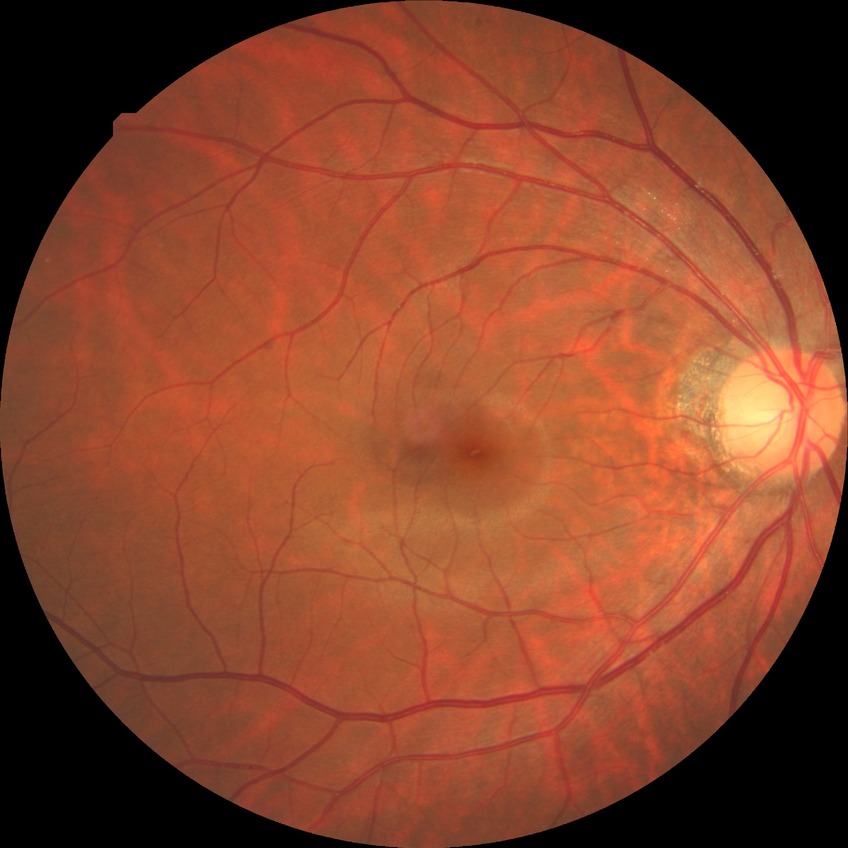

diabetic retinopathy (DR)=NDR (no diabetic retinopathy).